FOV: 45 degrees.
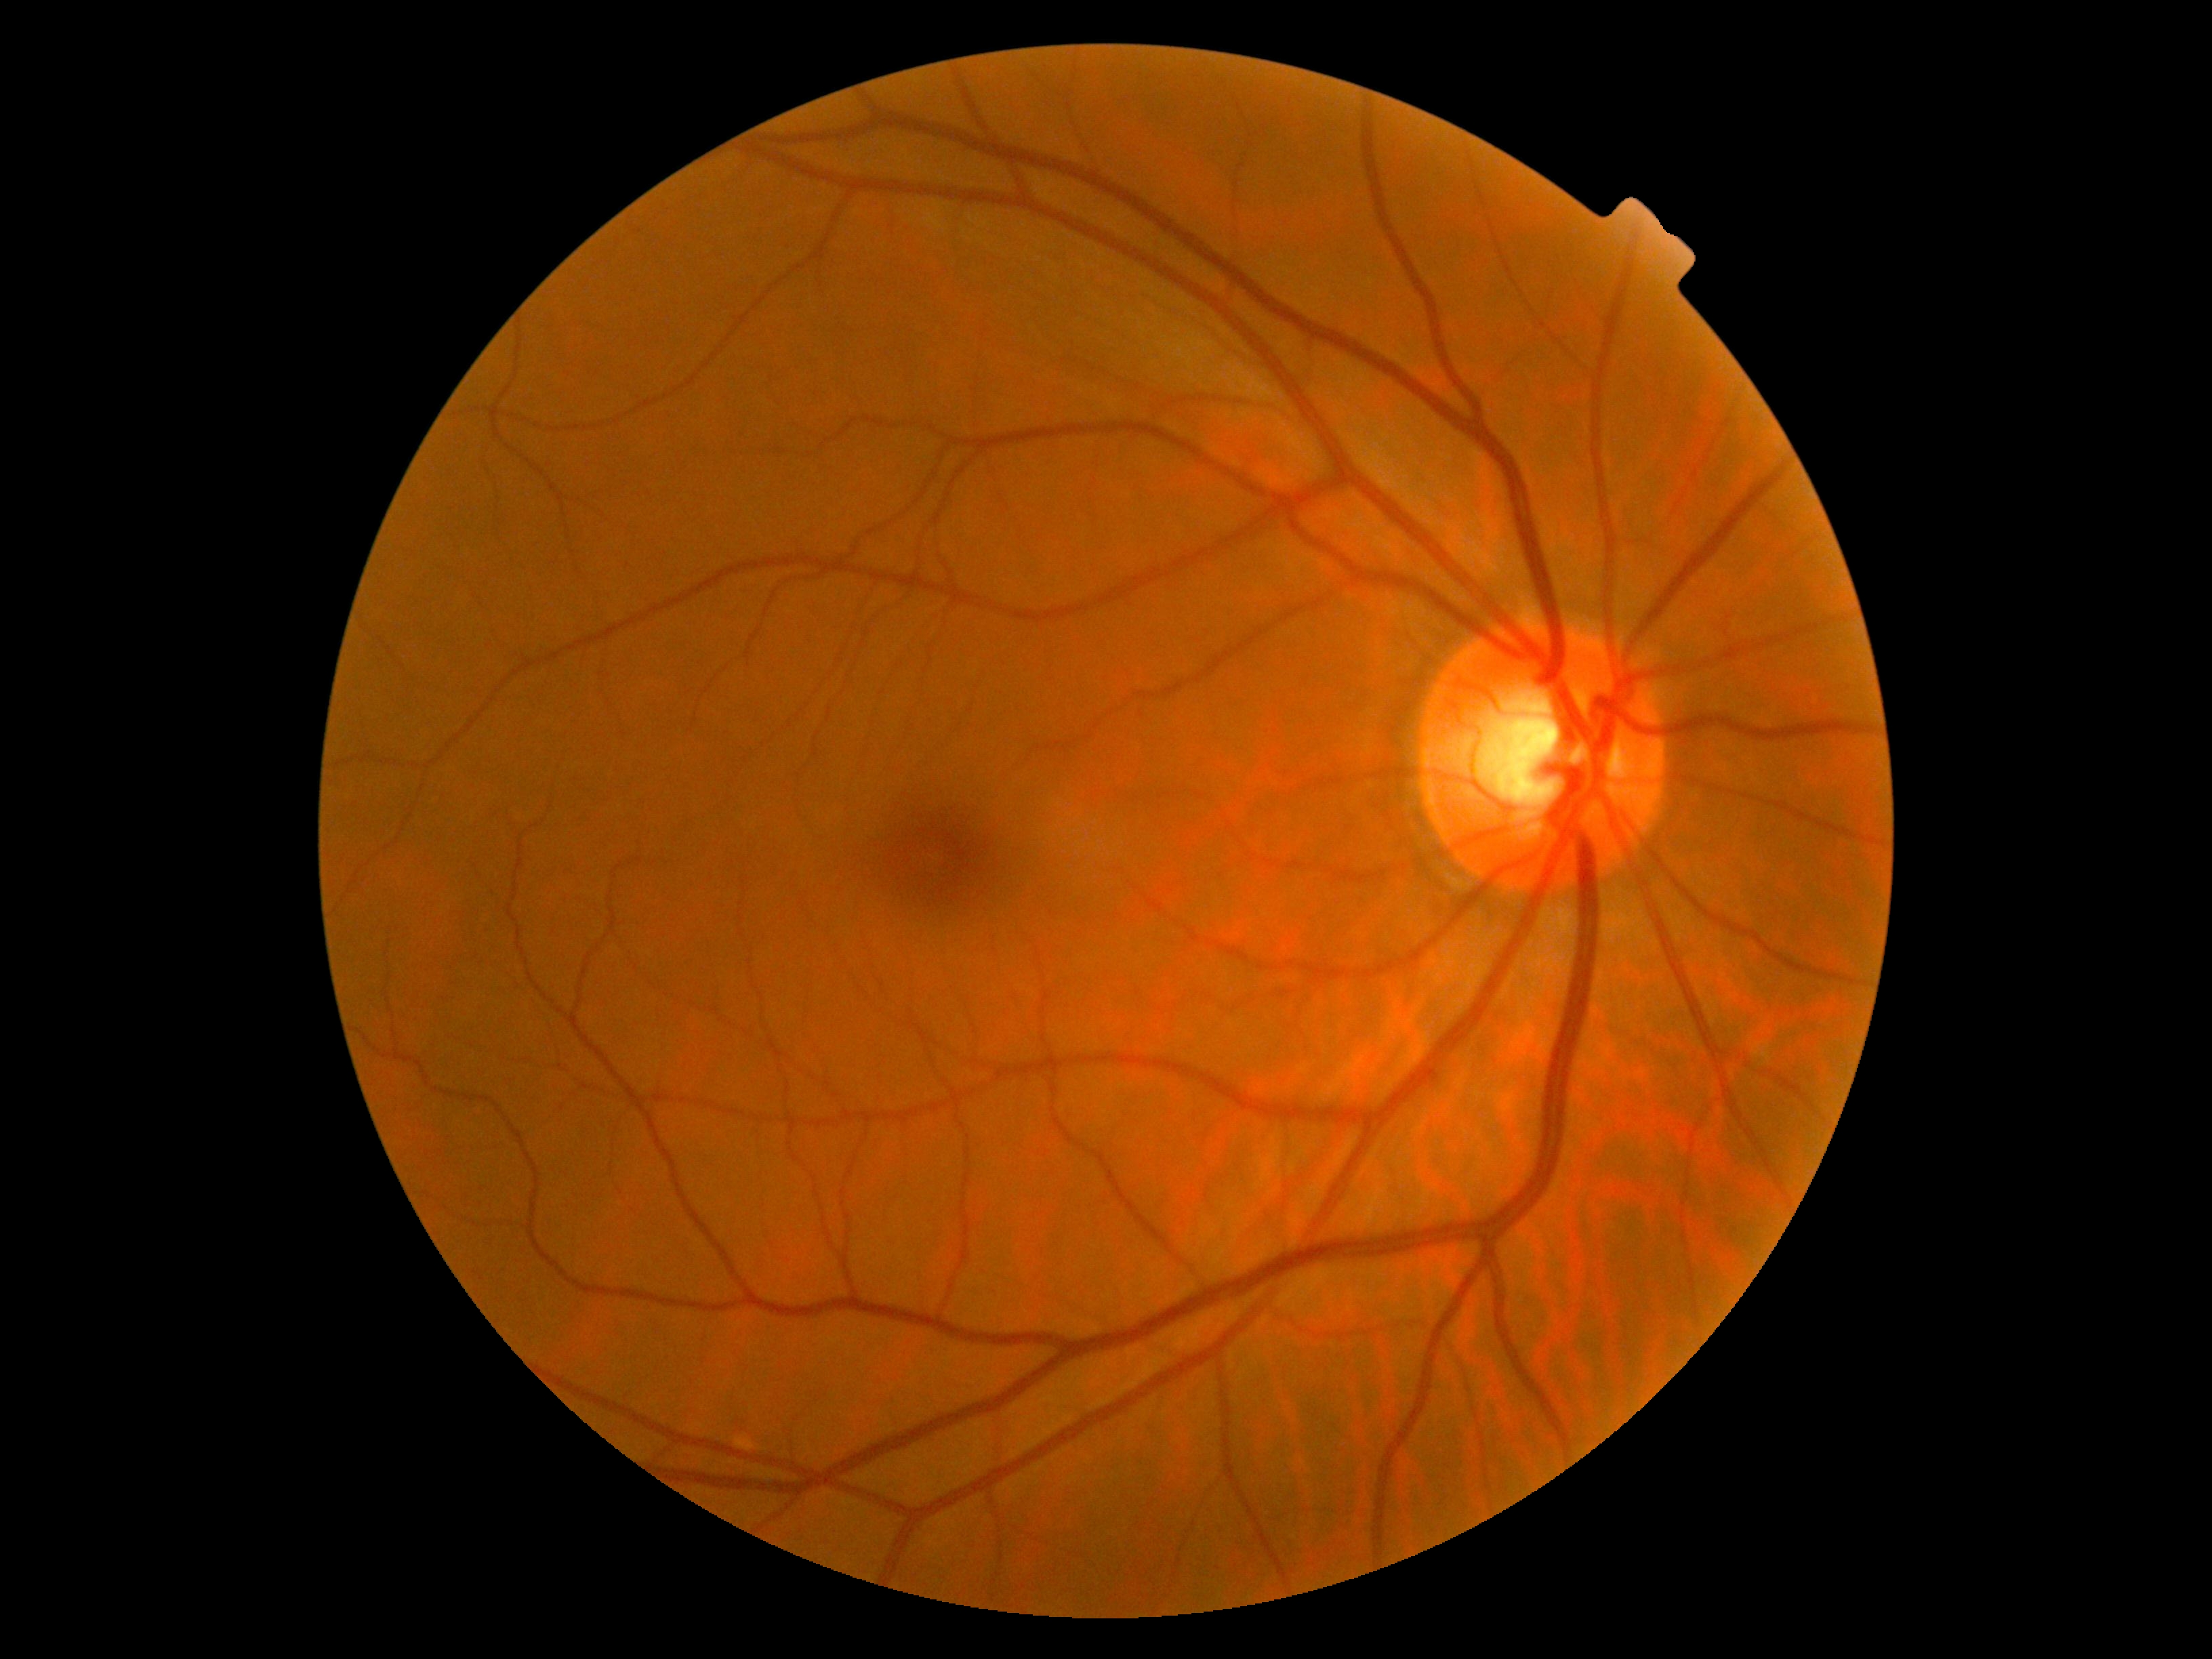

Diabetic retinopathy grade: 0 (no apparent retinopathy).